Acquired with a Nidek AFC-330:
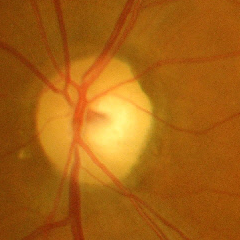 Glaucoma is present. Showing advanced glaucoma.